Wide-field contact fundus photograph of an infant. Captured with the Phoenix ICON (100° field of view)
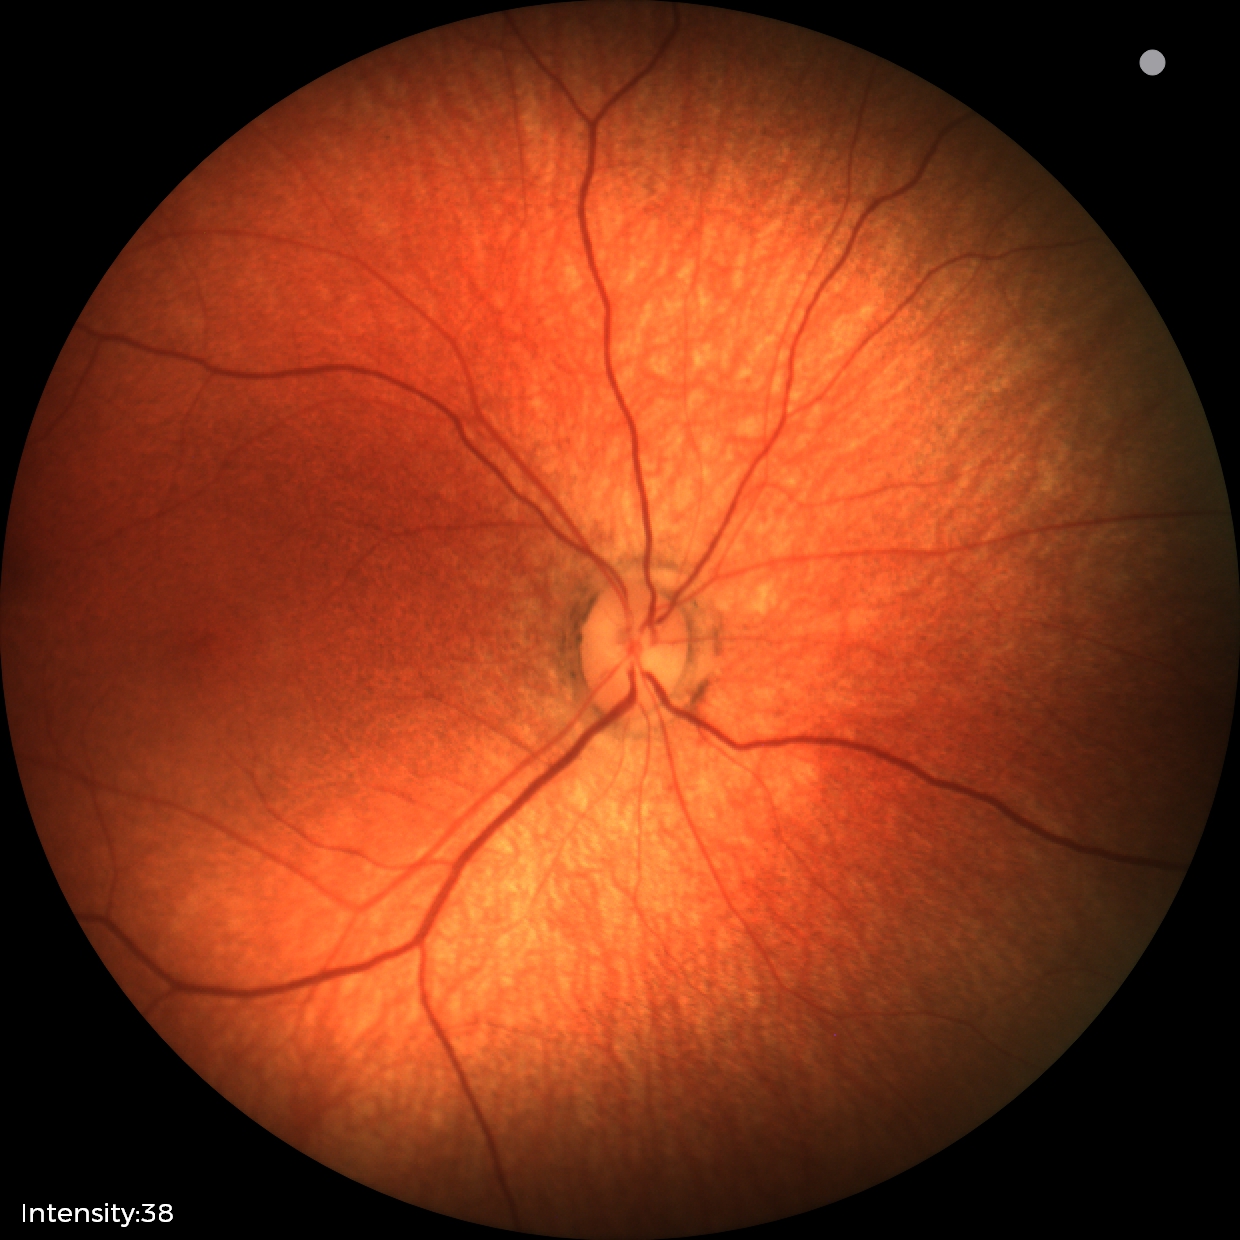

Assessment: normal.